Wide-field fundus image from infant ROP screening.
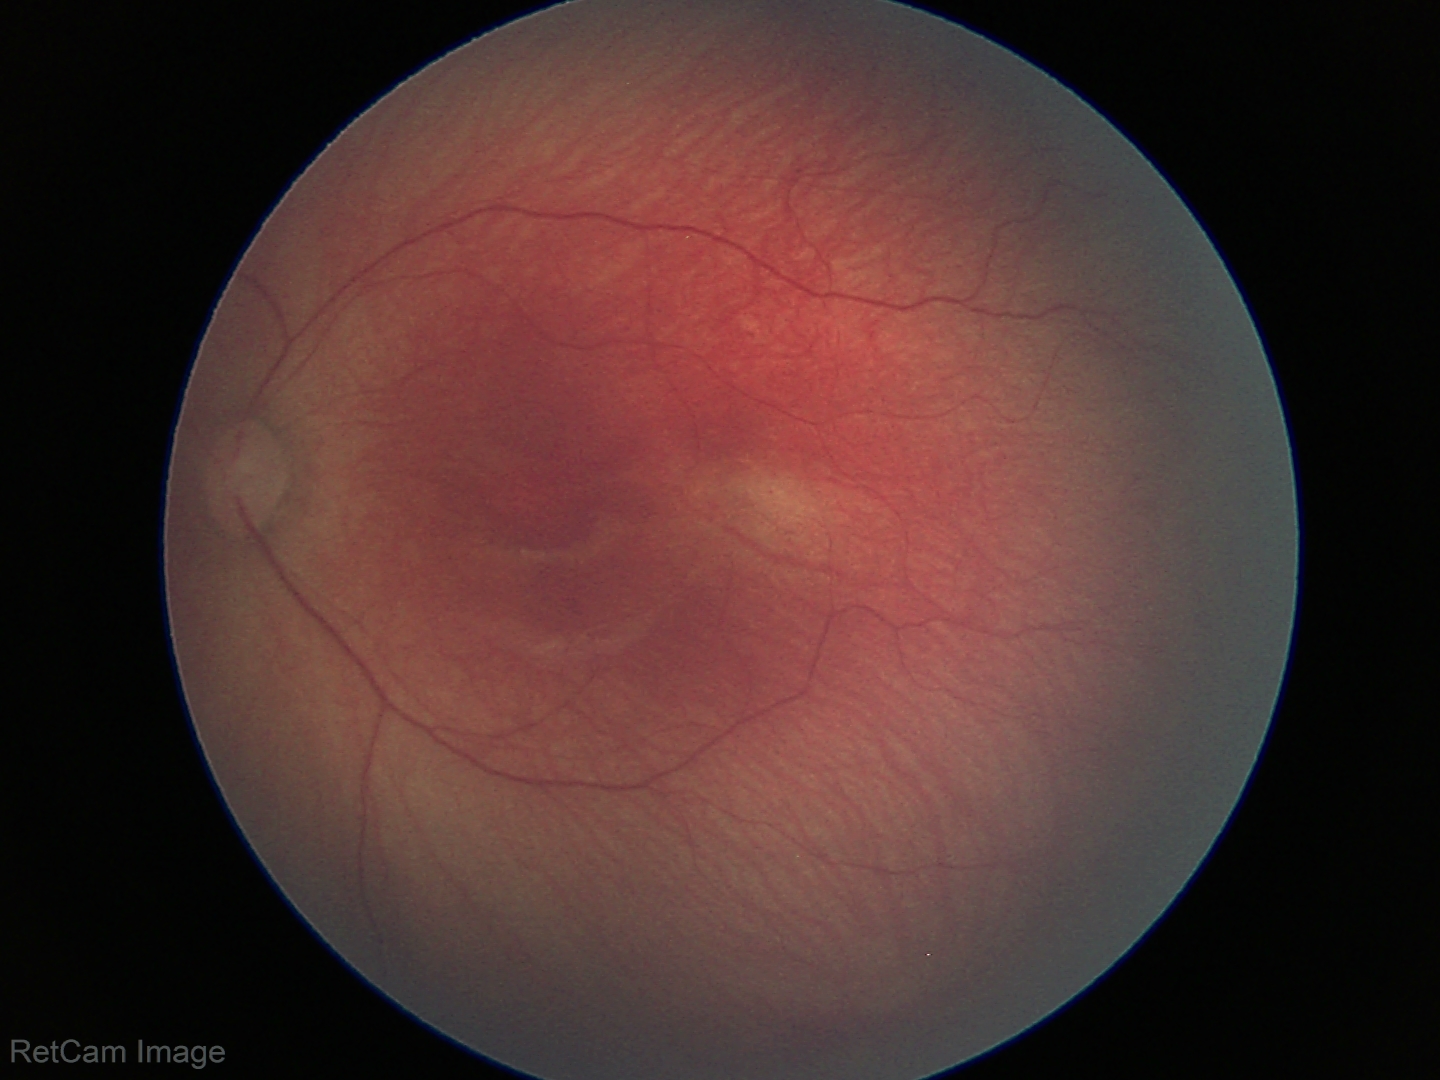
Series diagnosed as ROP stage 1. No plus disease.